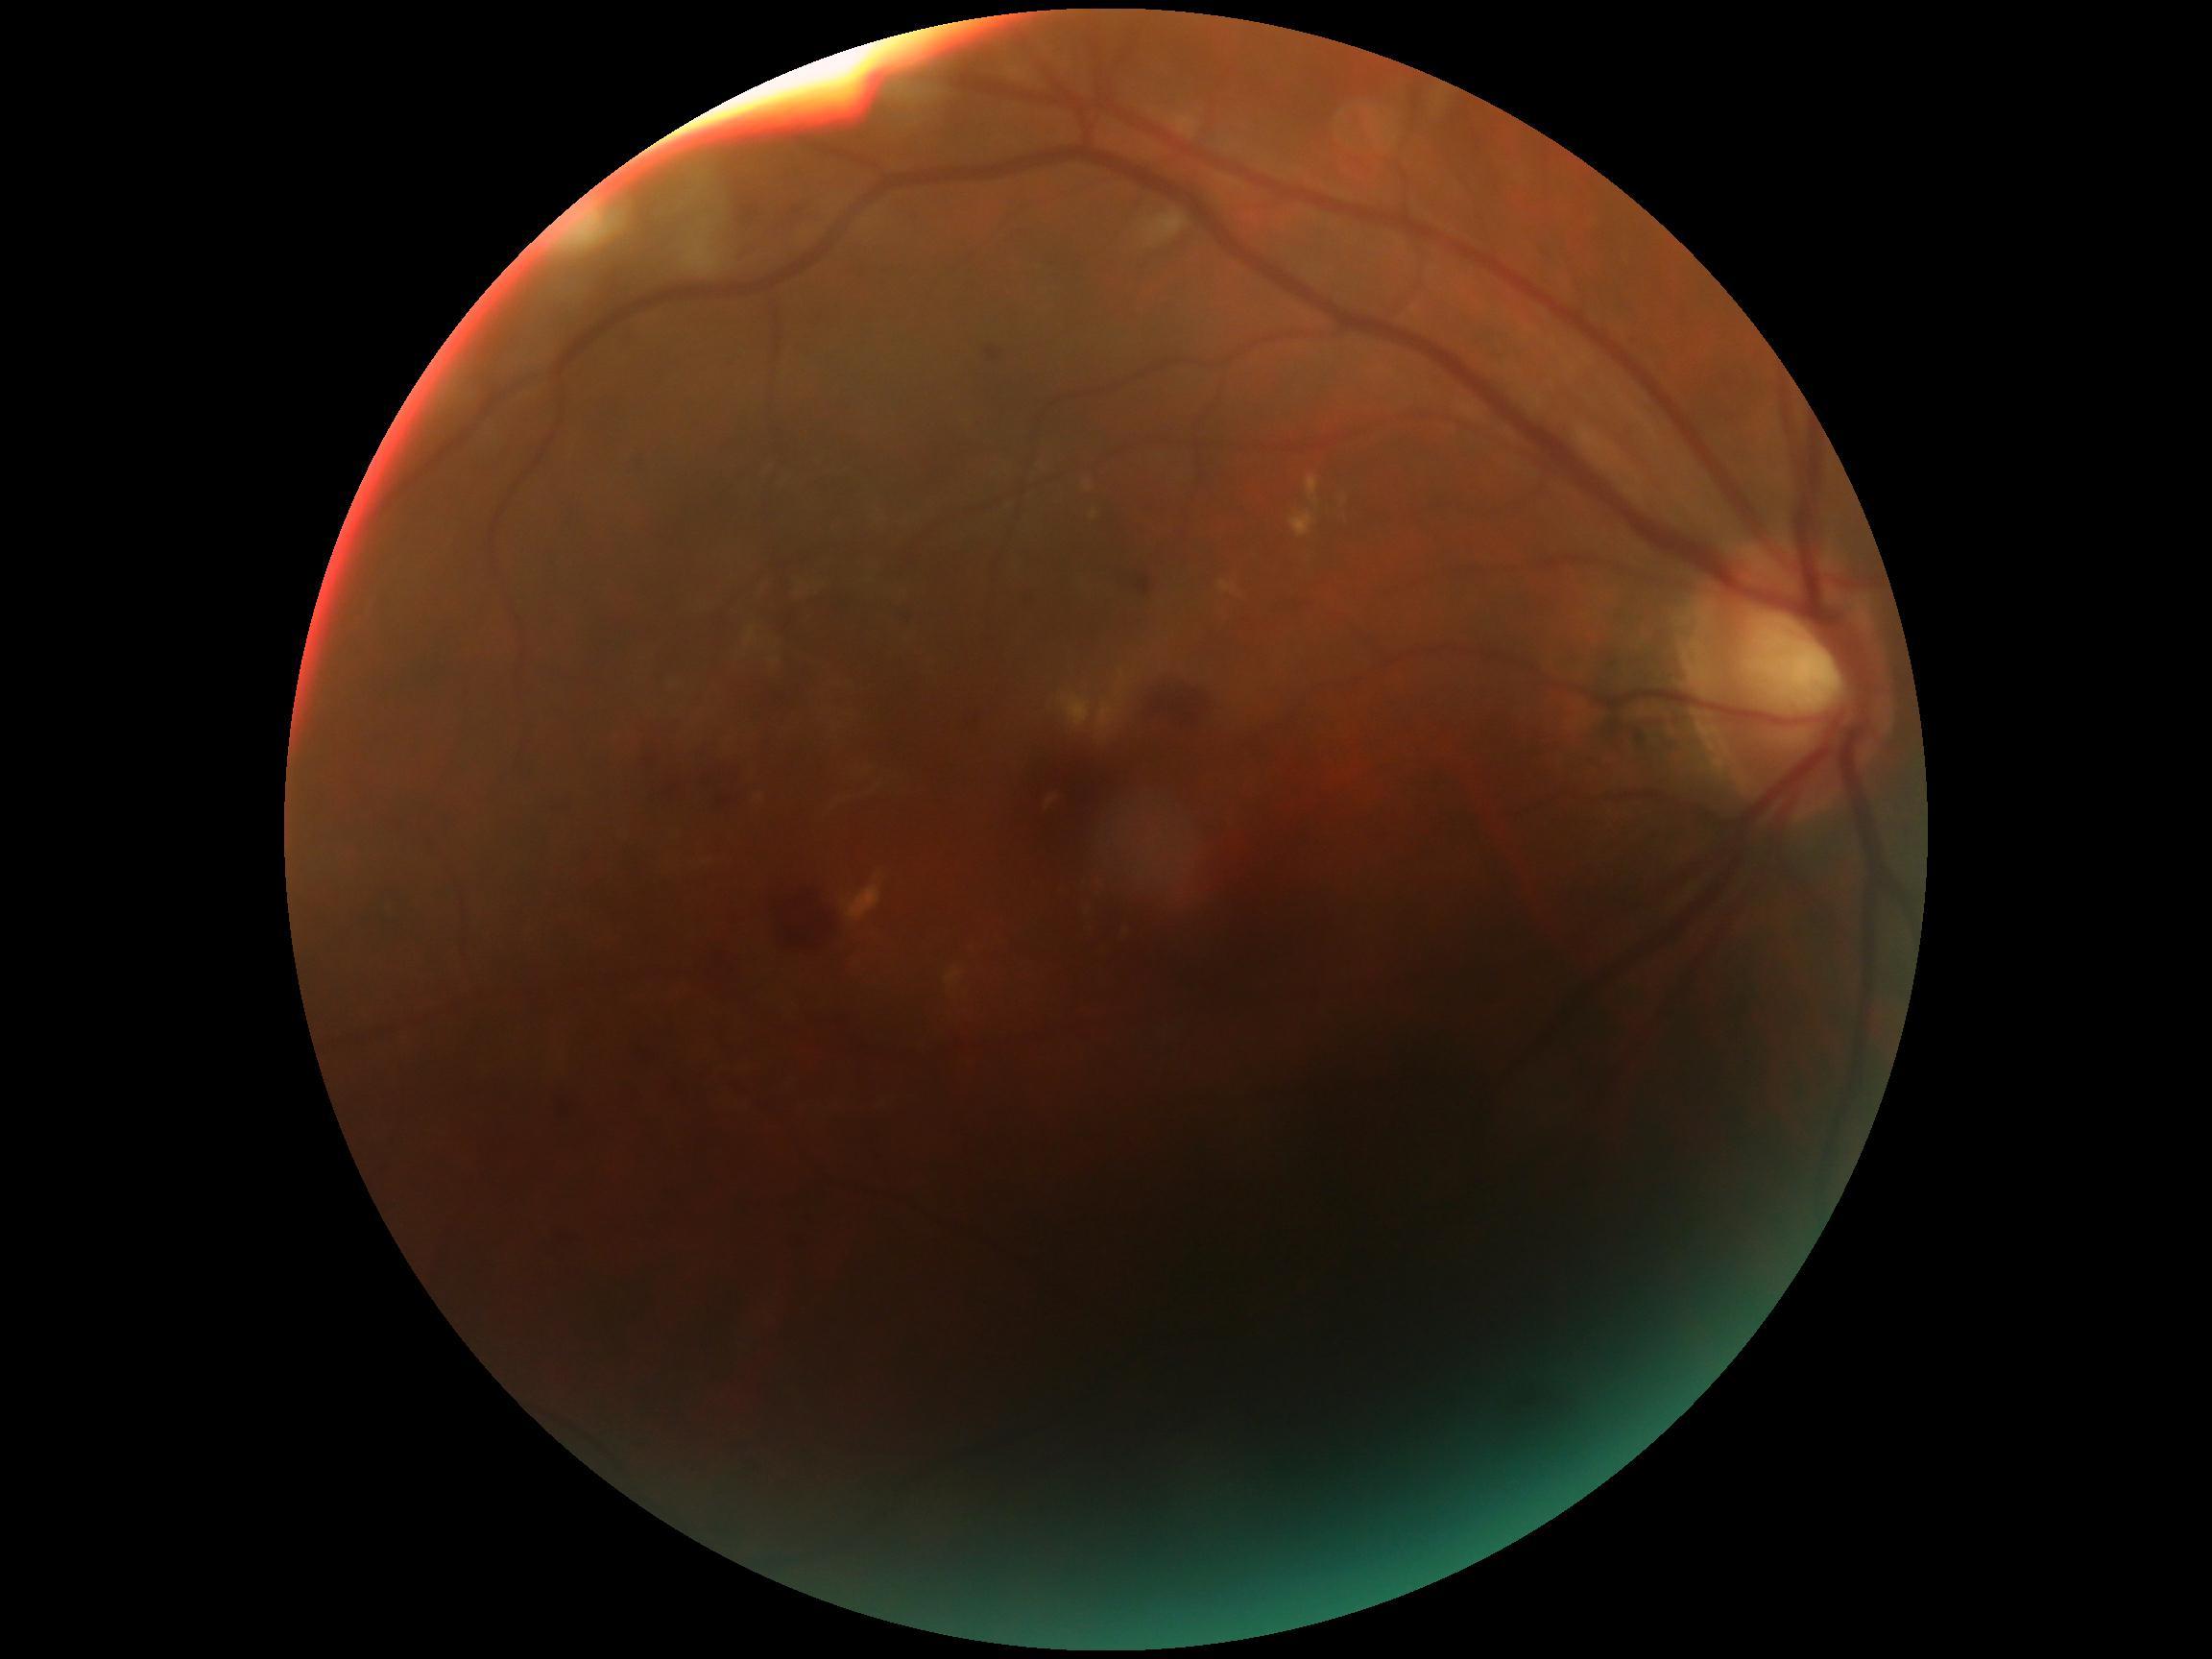 DR stage is moderate non-proliferative diabetic retinopathy (grade 2).